Captured on a Remidio Fundus on Phone, retinal fundus photograph, 1659x2212
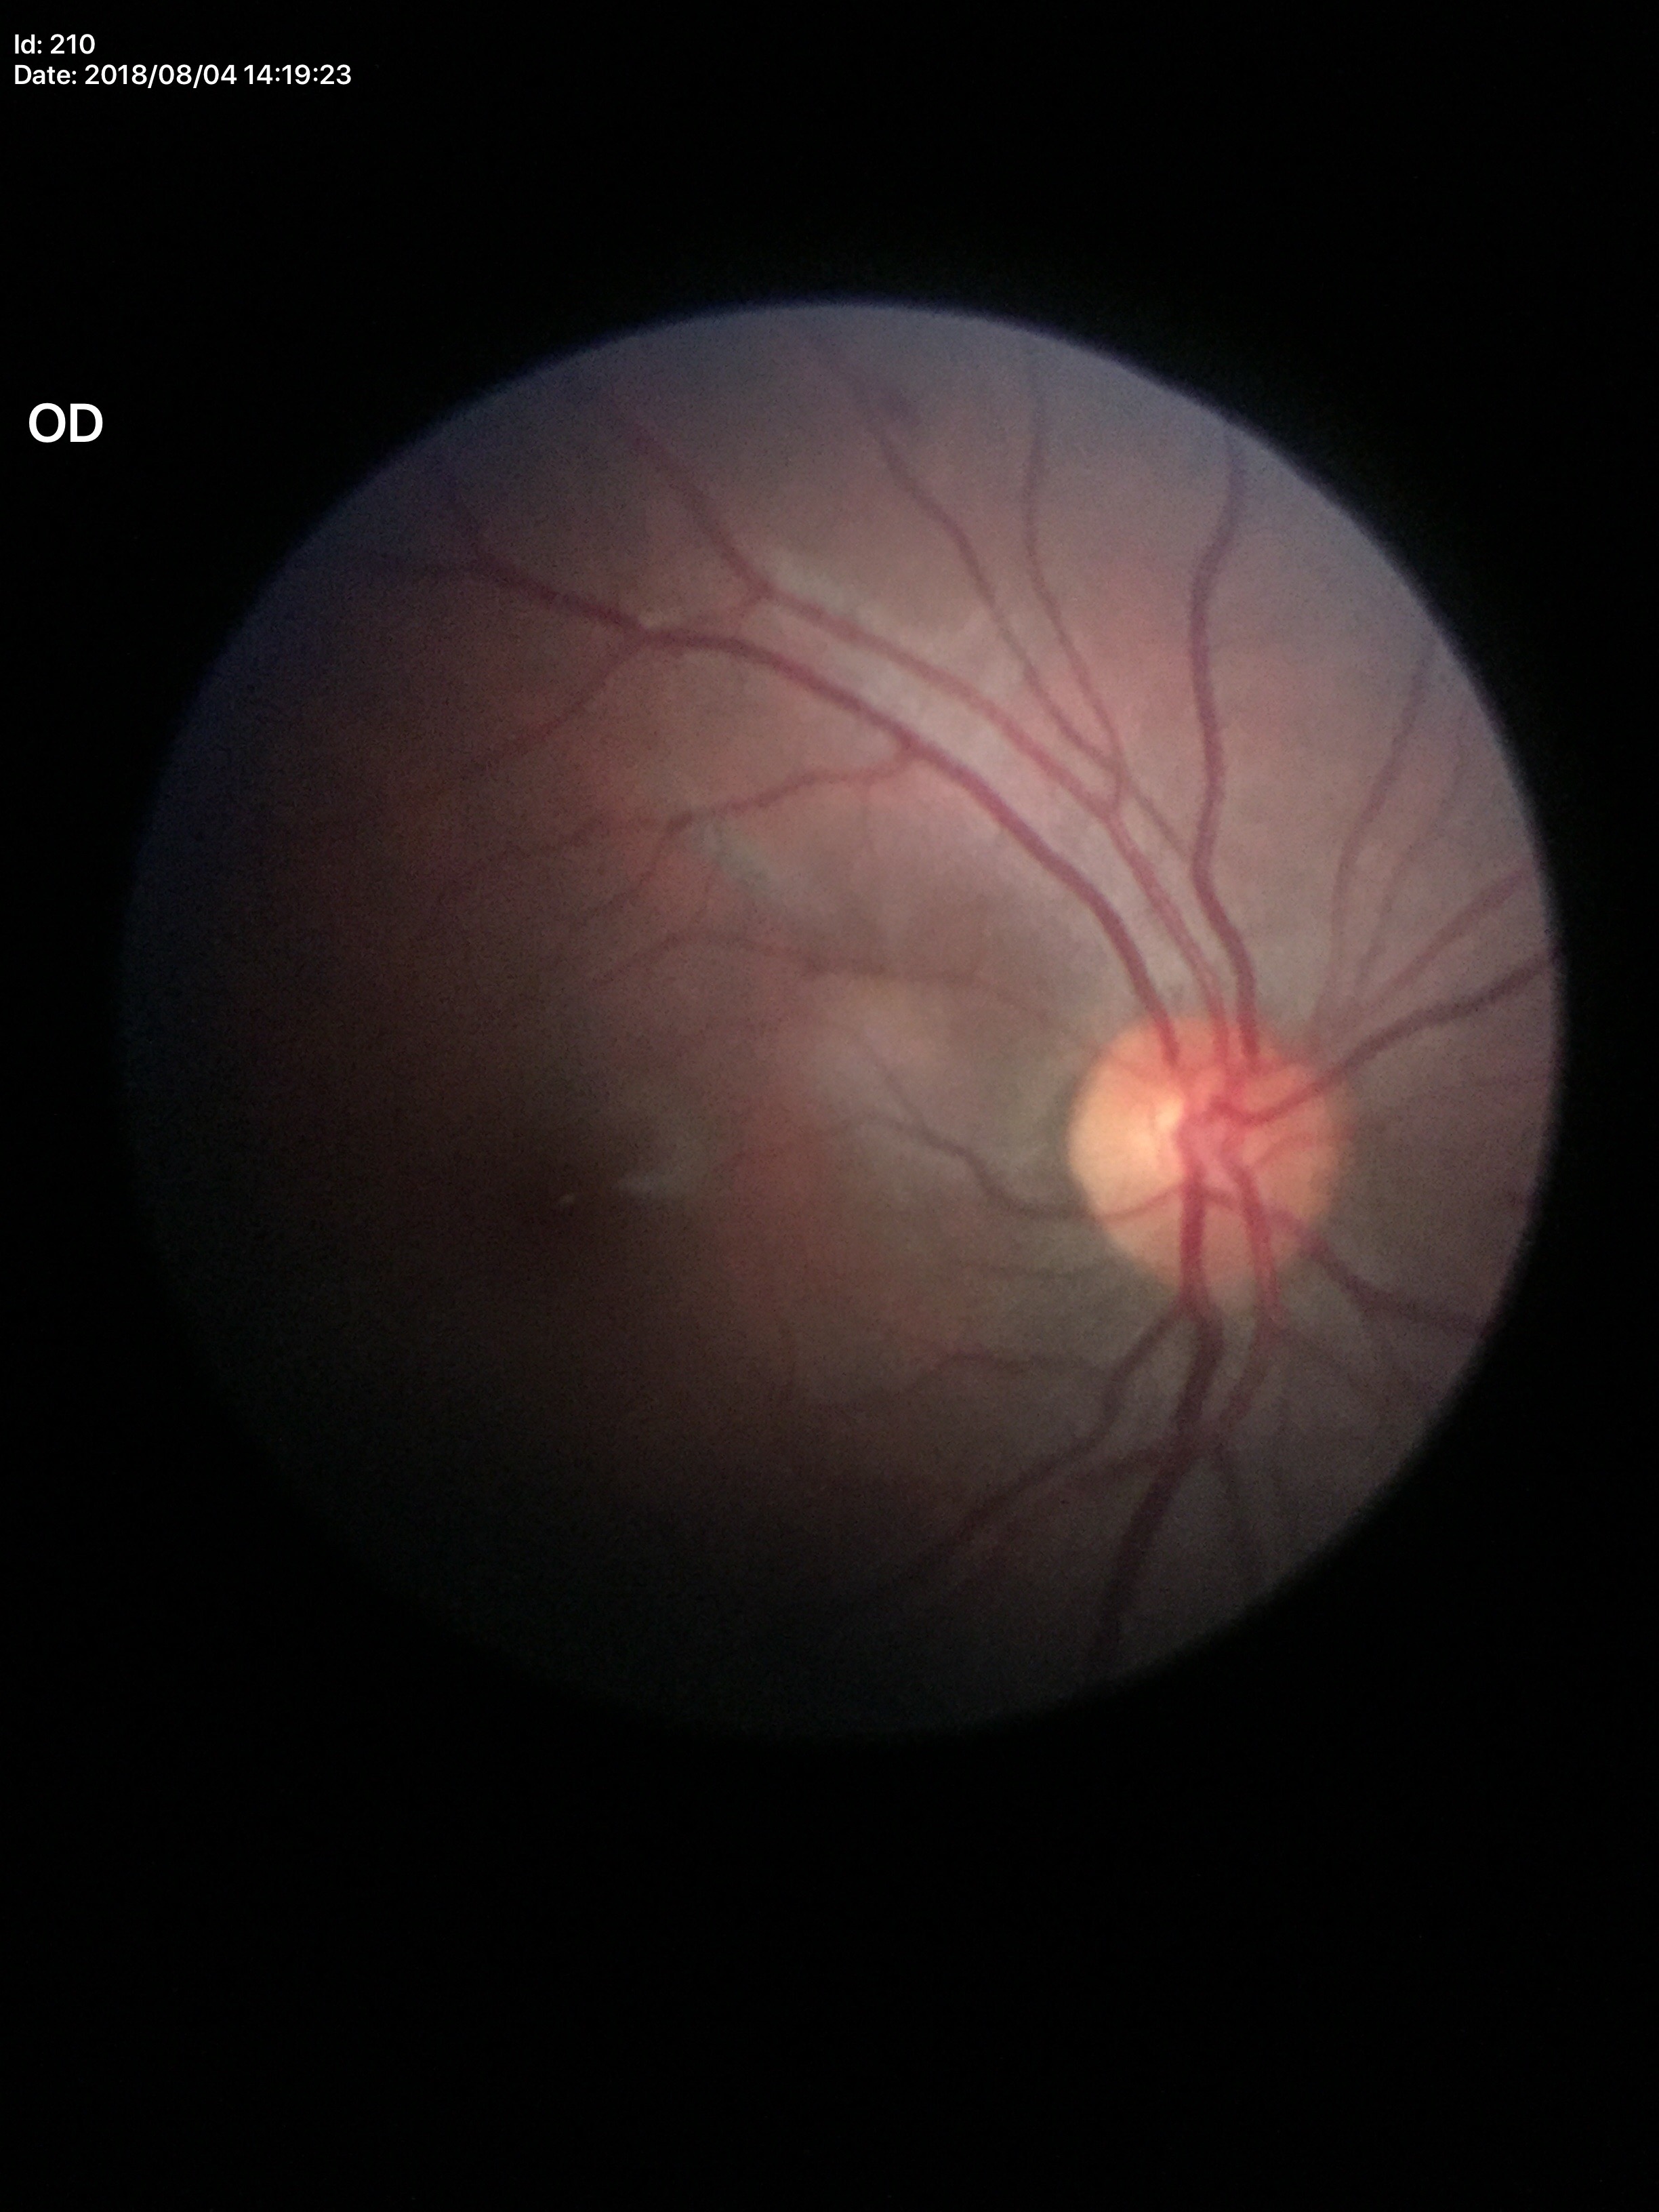
Glaucoma impression: negative (all 5 graders called normal).
Vertical cup-disc ratio (VCDR) of 0.51.